Wide-field fundus photograph from neonatal ROP screening:
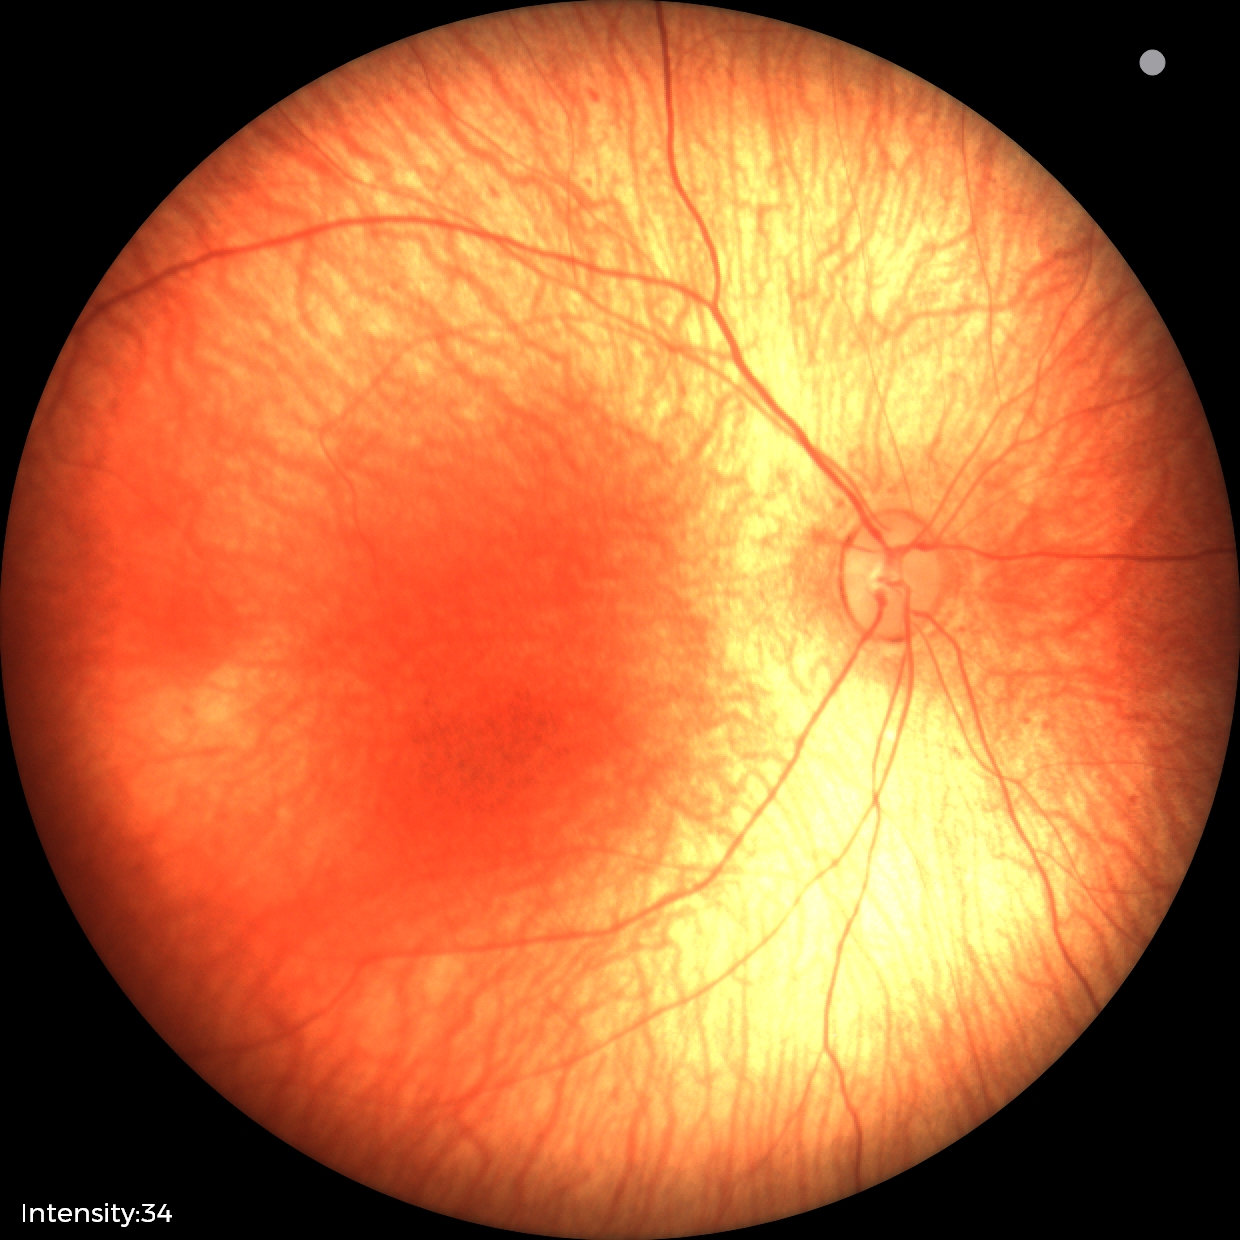
Impression: physiological.